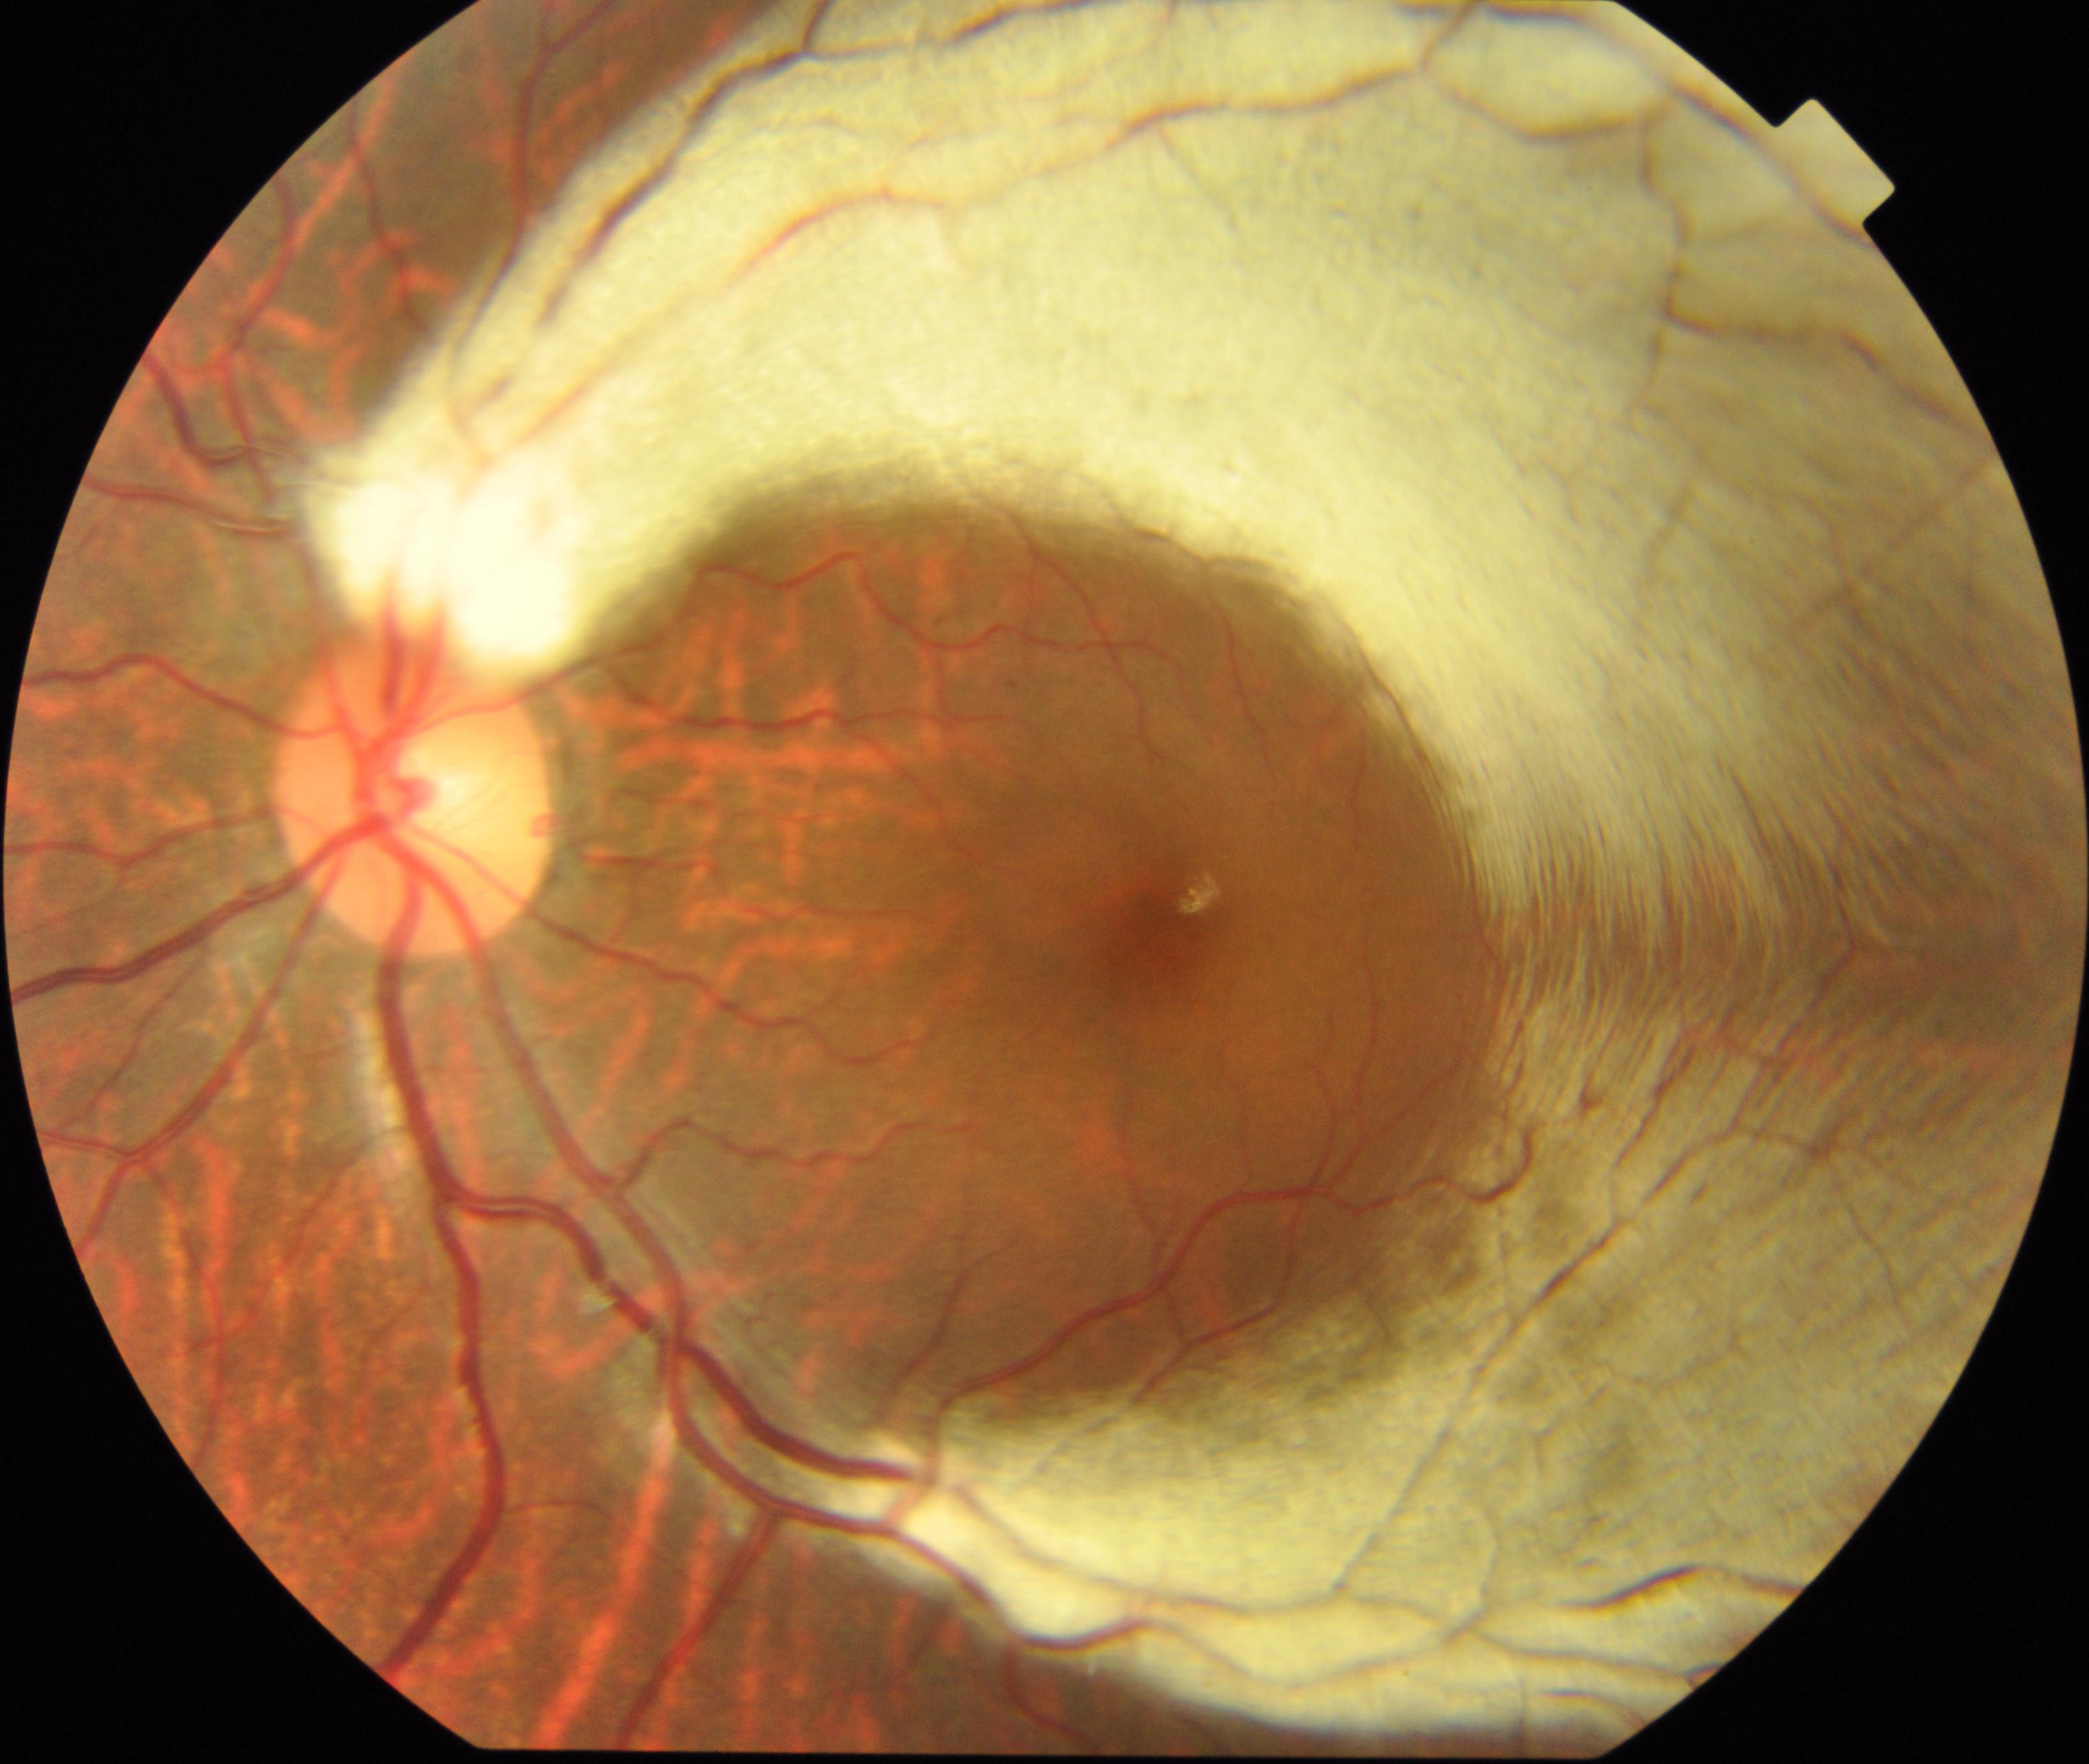
Primary finding: myelinated nerve fibers.